45° field of view; 2352x1568px; color fundus photograph
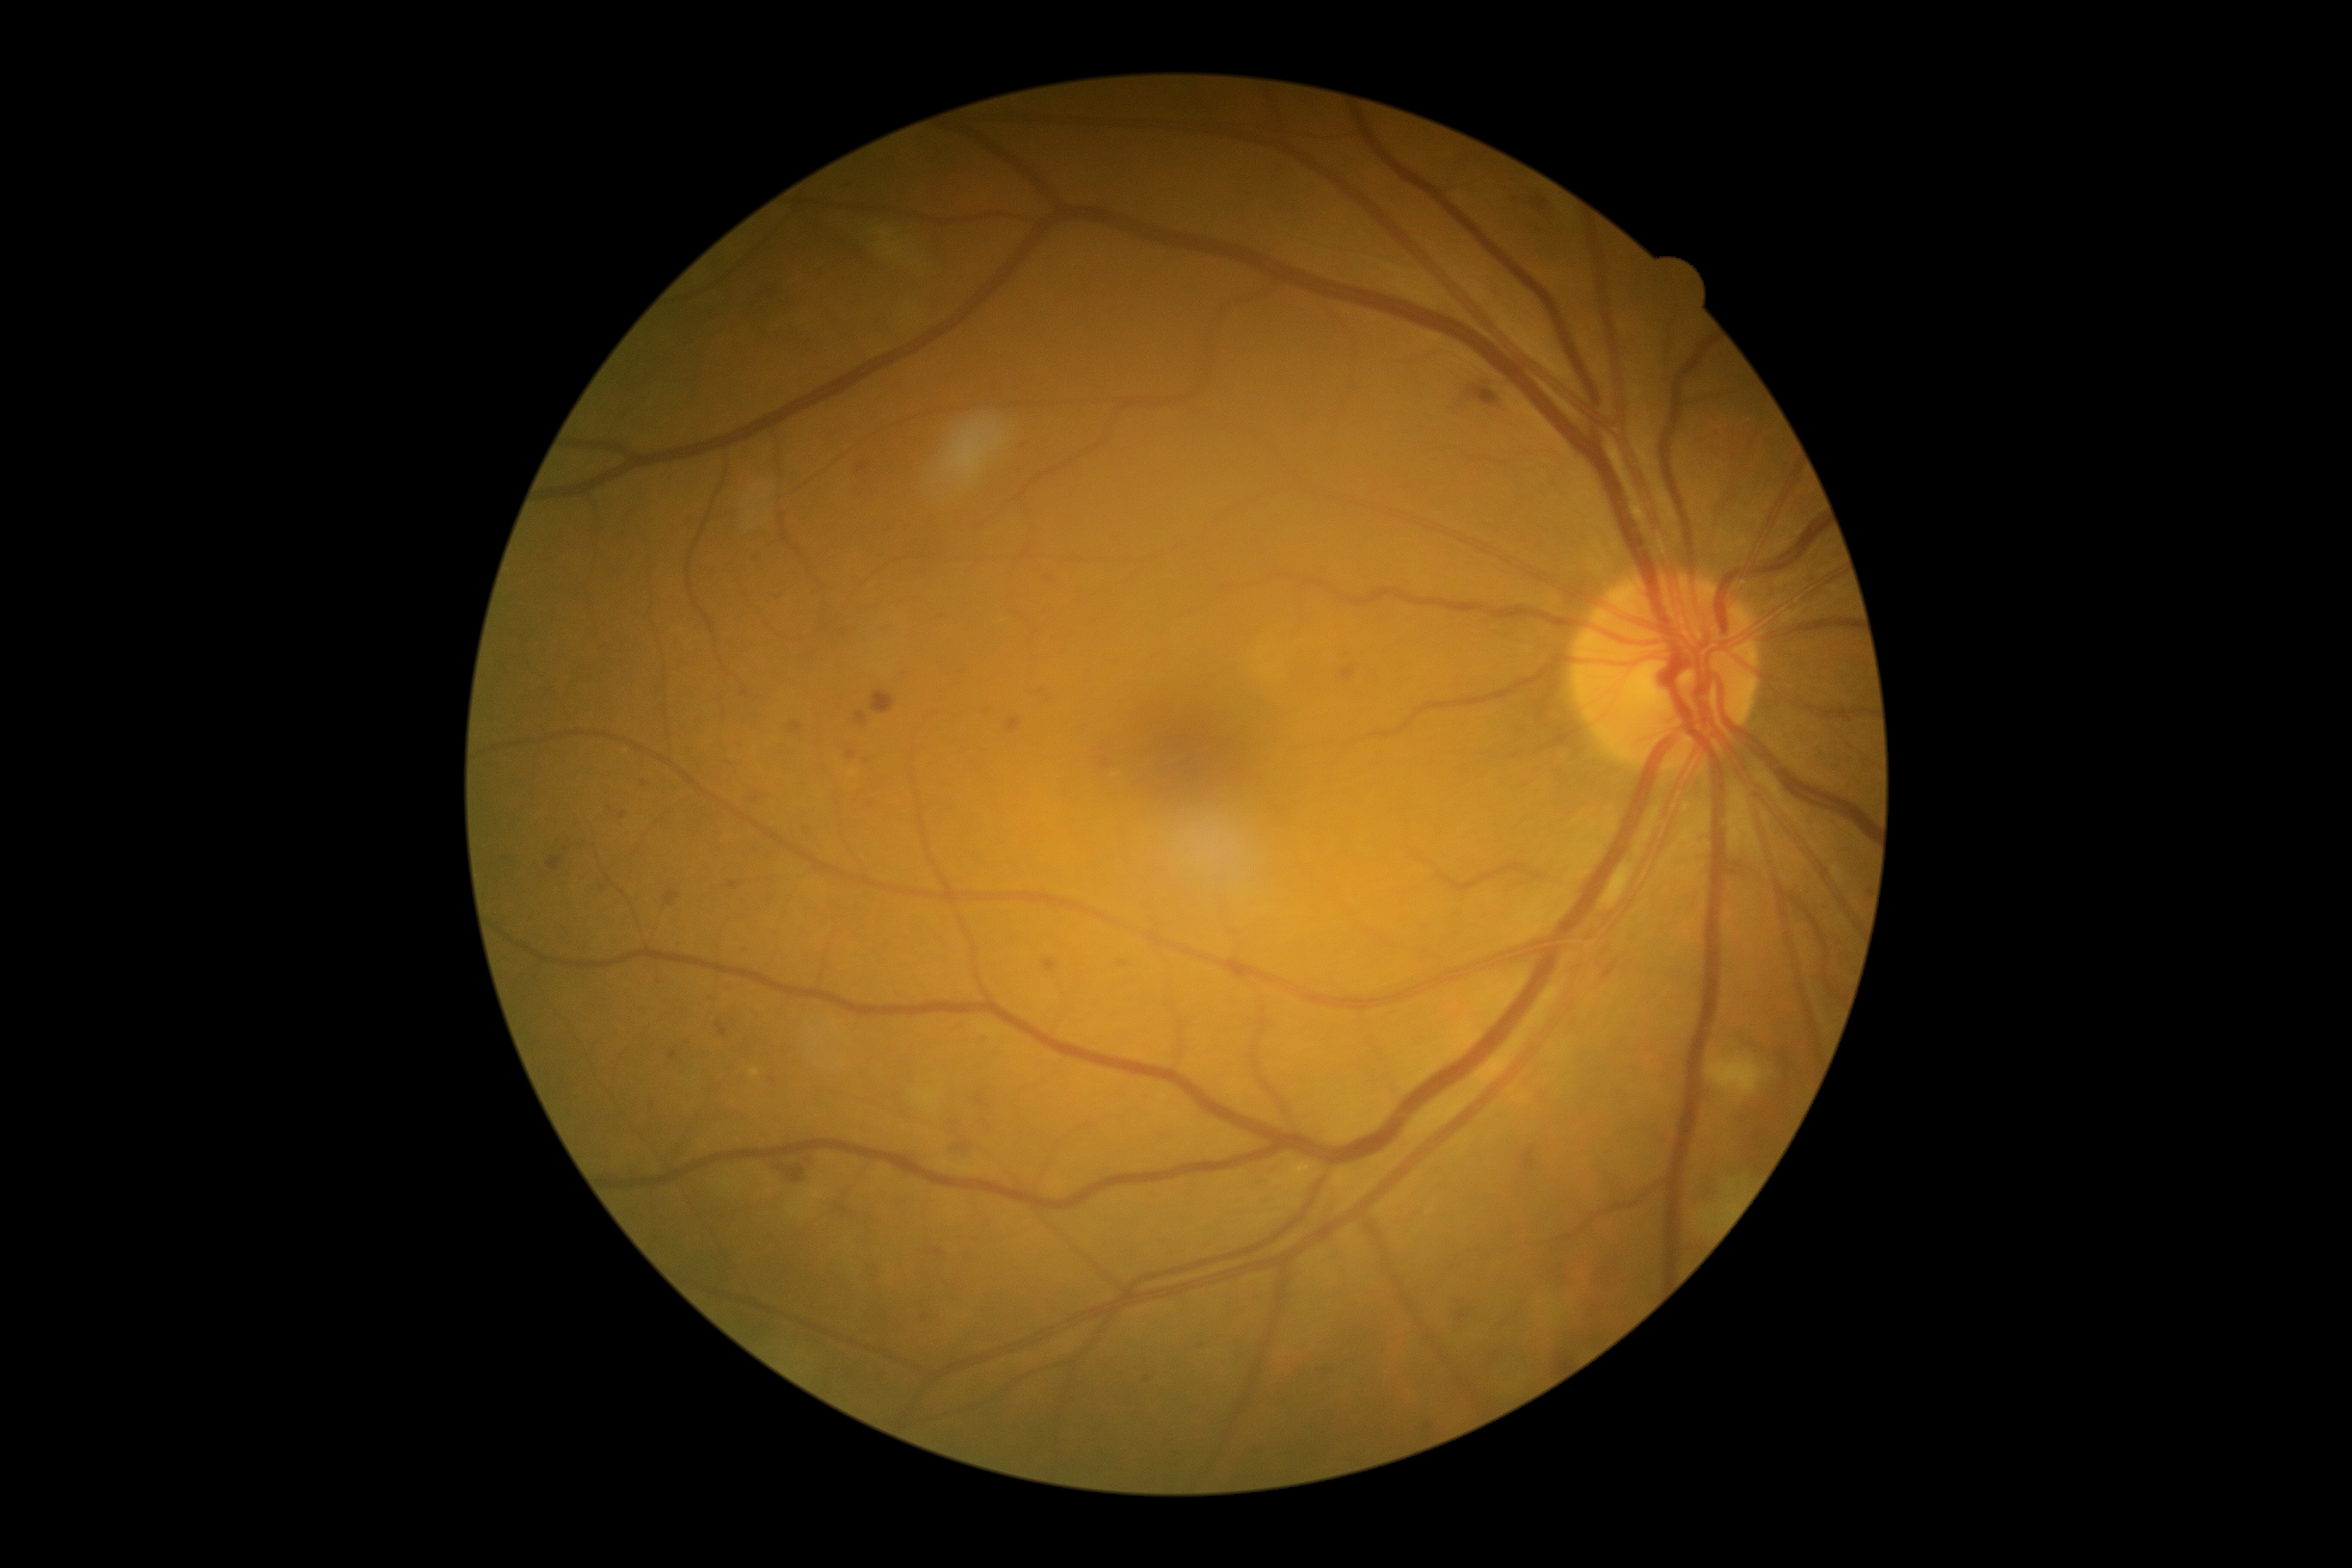 {"partial":true,"dr_grade":2,"dr_grade_name":"moderate NPDR","lesions":{"ma":[[957,1141,971,1151],[847,750,857,761],[976,1096,984,1106],[941,613,950,622],[1603,962,1617,979],[716,1020,728,1038],[740,690,749,697],[1342,668,1356,682],[1457,1311,1466,1320],[1024,441,1029,450]],"ma_small_approx":[[871,805],[565,849],[1201,1347],[756,800],[867,761]]}}